Color fundus image.
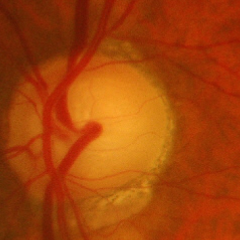 Q: Does this eye have glaucoma?
A: Yes — advanced glaucomatous optic neuropathy.